1240 x 1240 pixels · pediatric wide-field fundus photograph
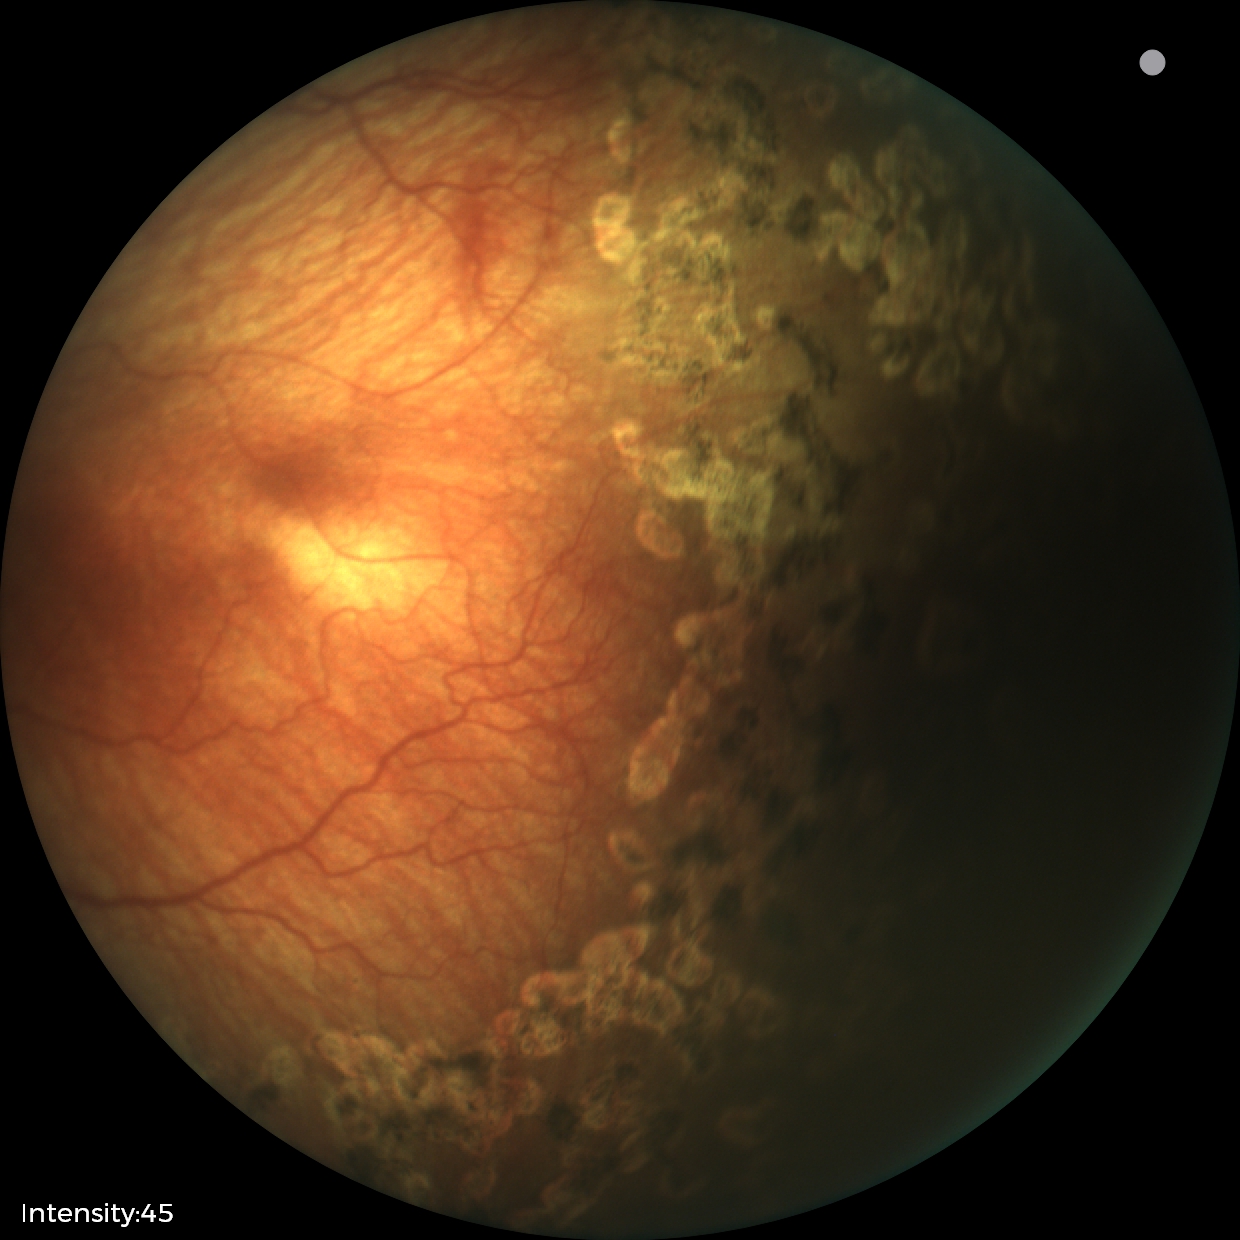

Examination diagnosed as status post ROP. Without plus disease.